Color fundus image — 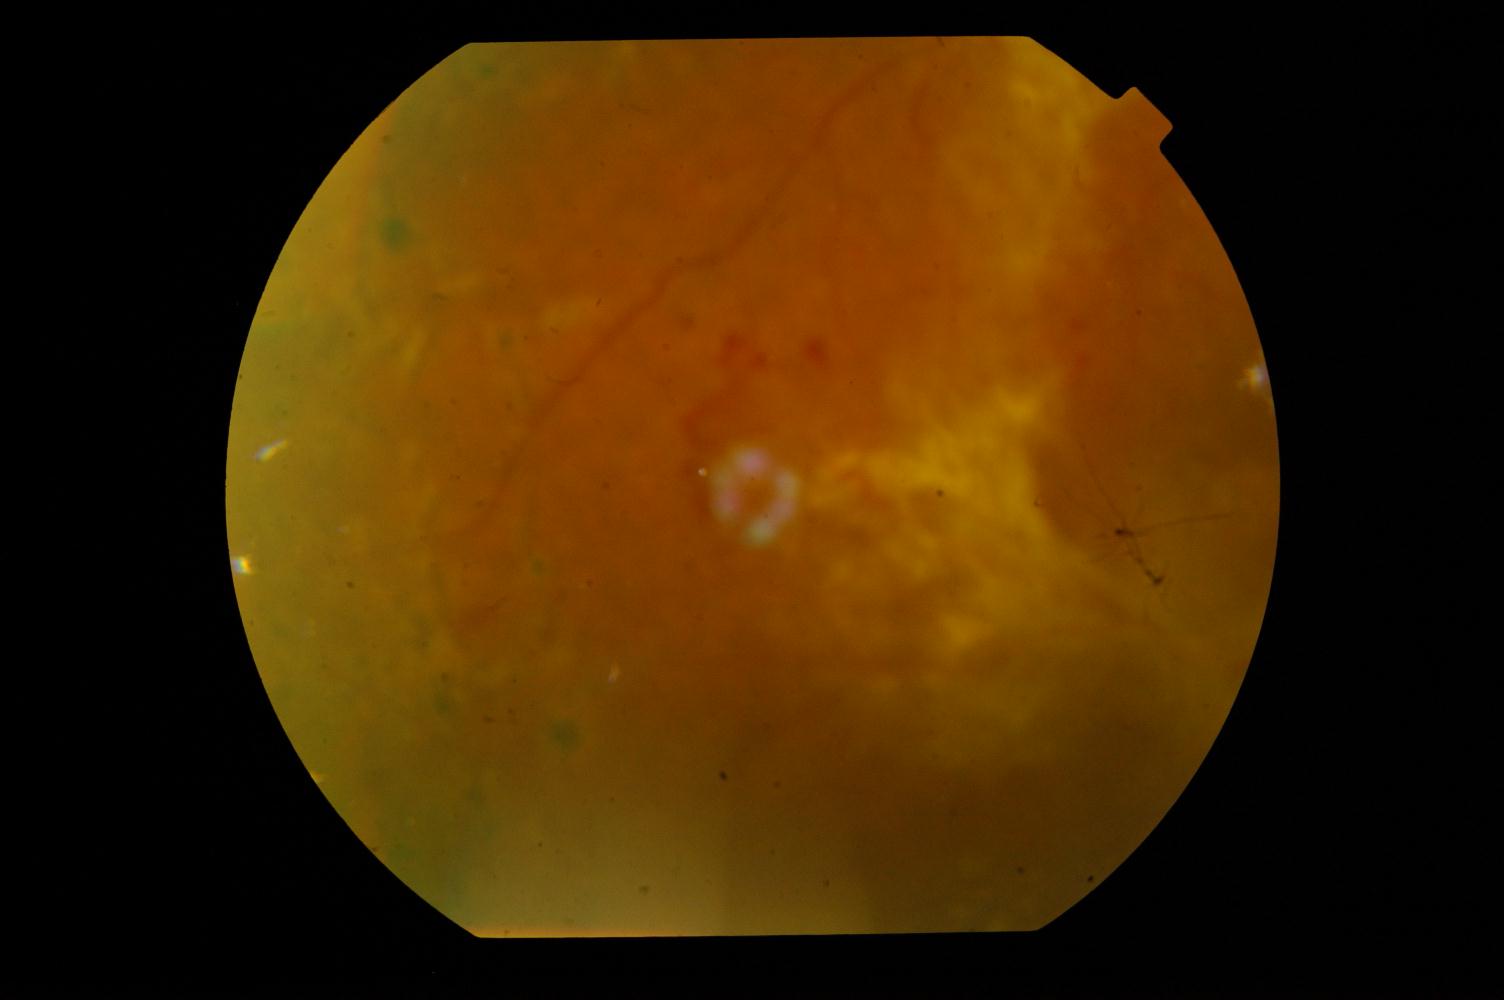 Impression: diabetic retinopathy (DR).